45° field of view. Retinal fundus photograph. 2048 by 1536 pixels:
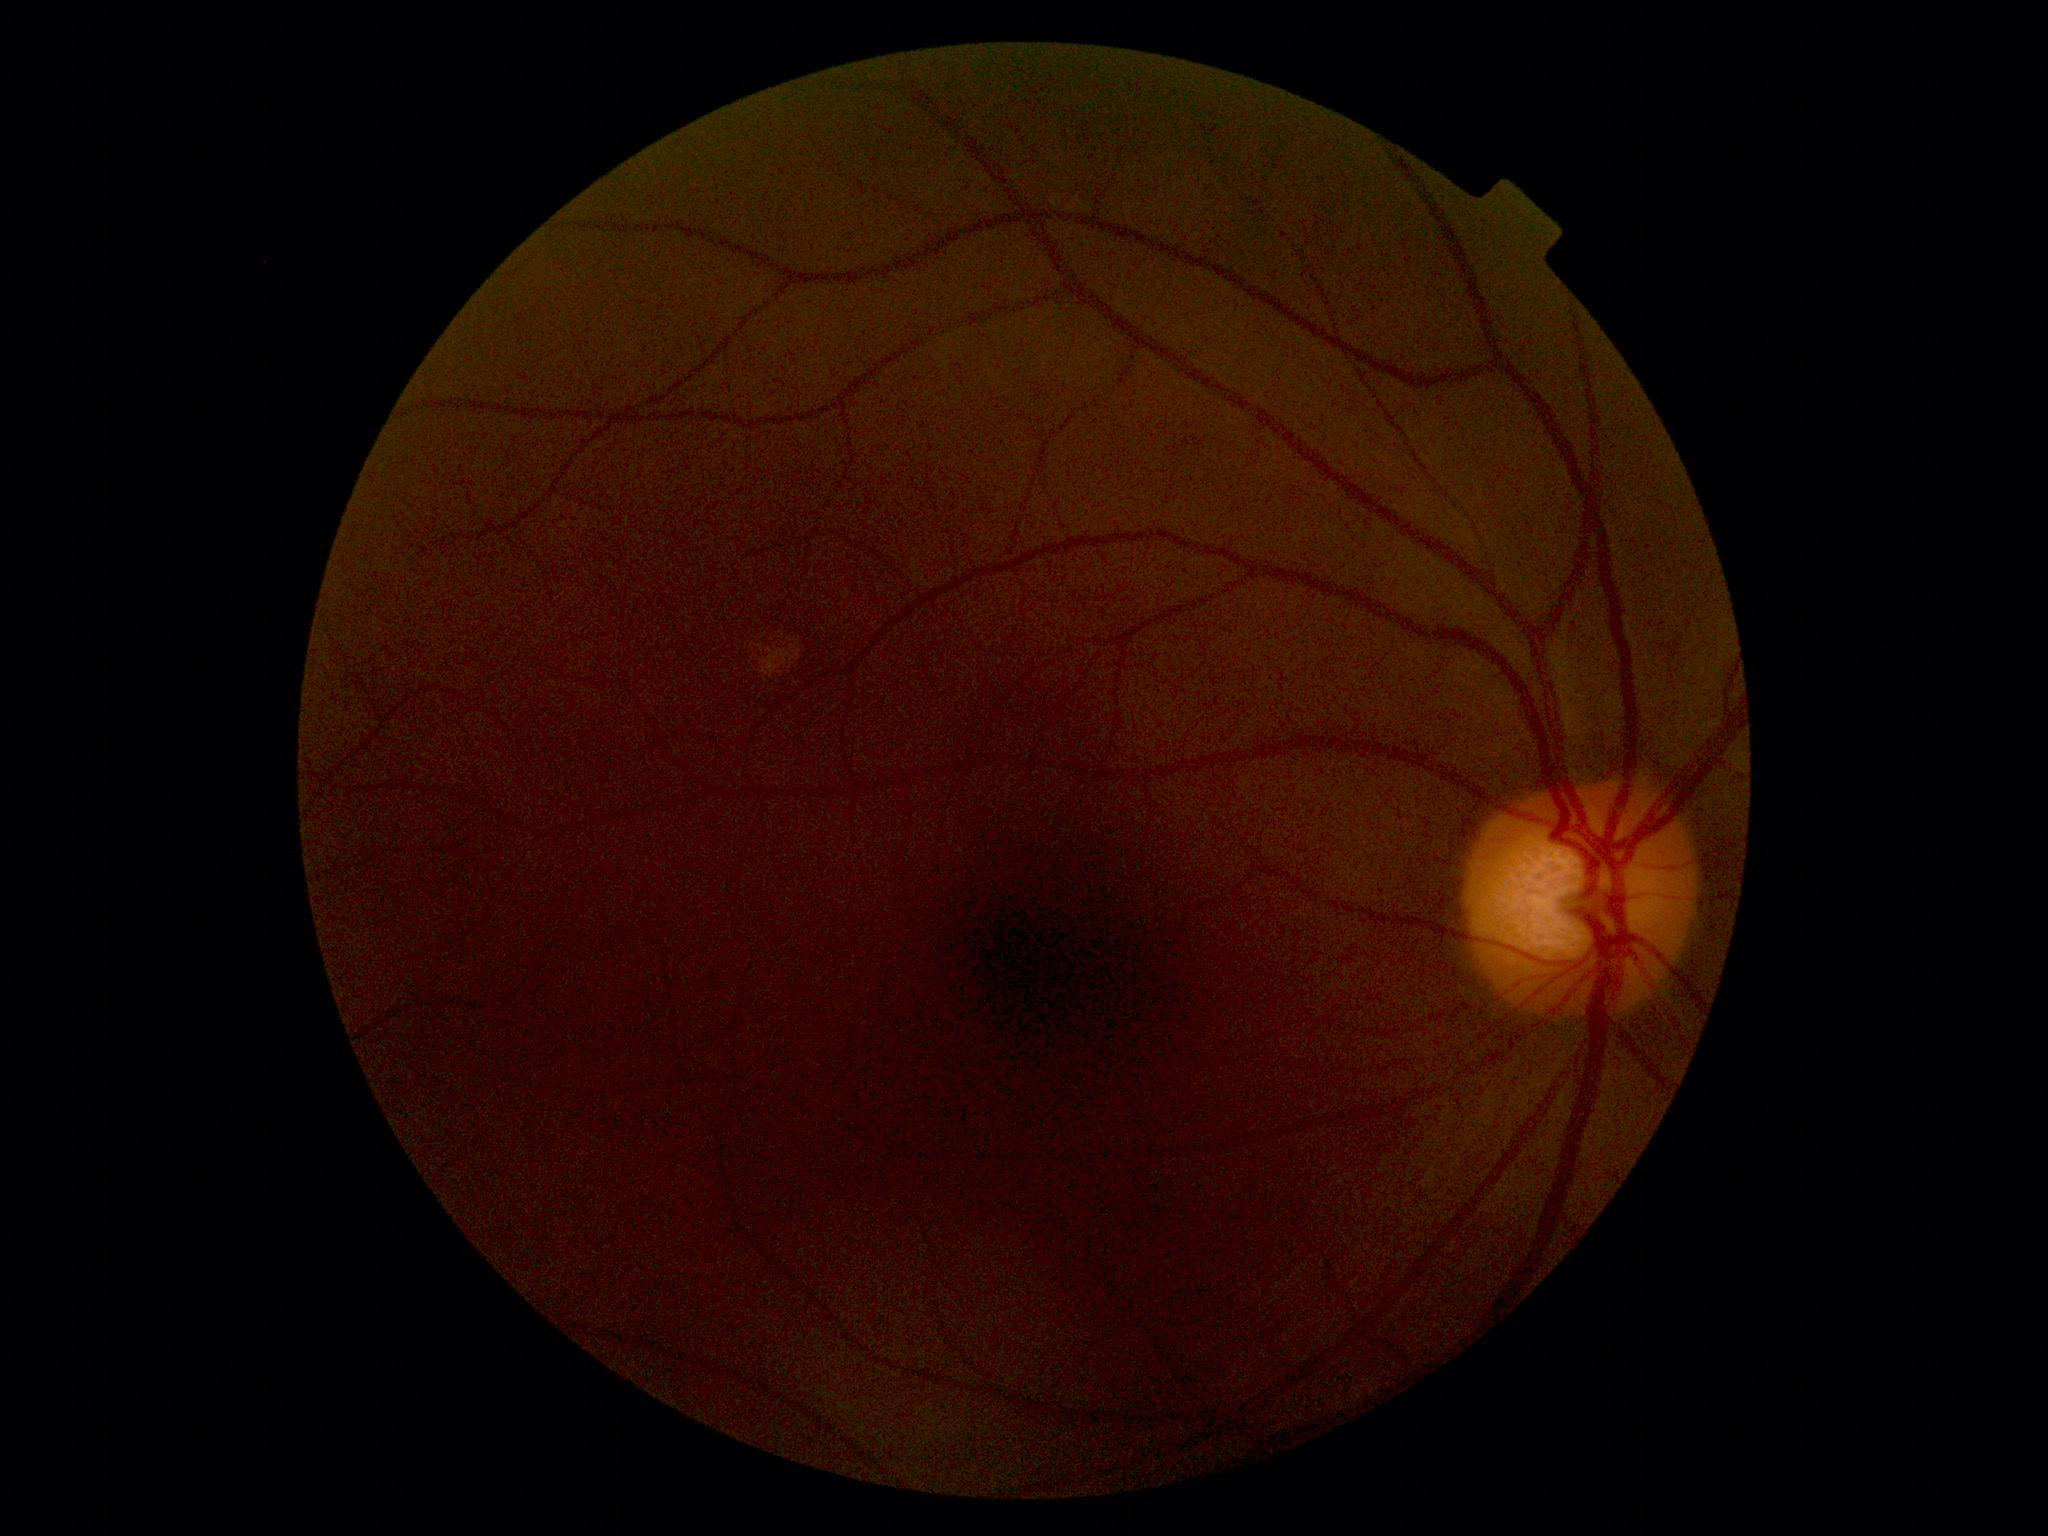 diabetic retinopathy (DR) = no apparent retinopathy (grade 0).